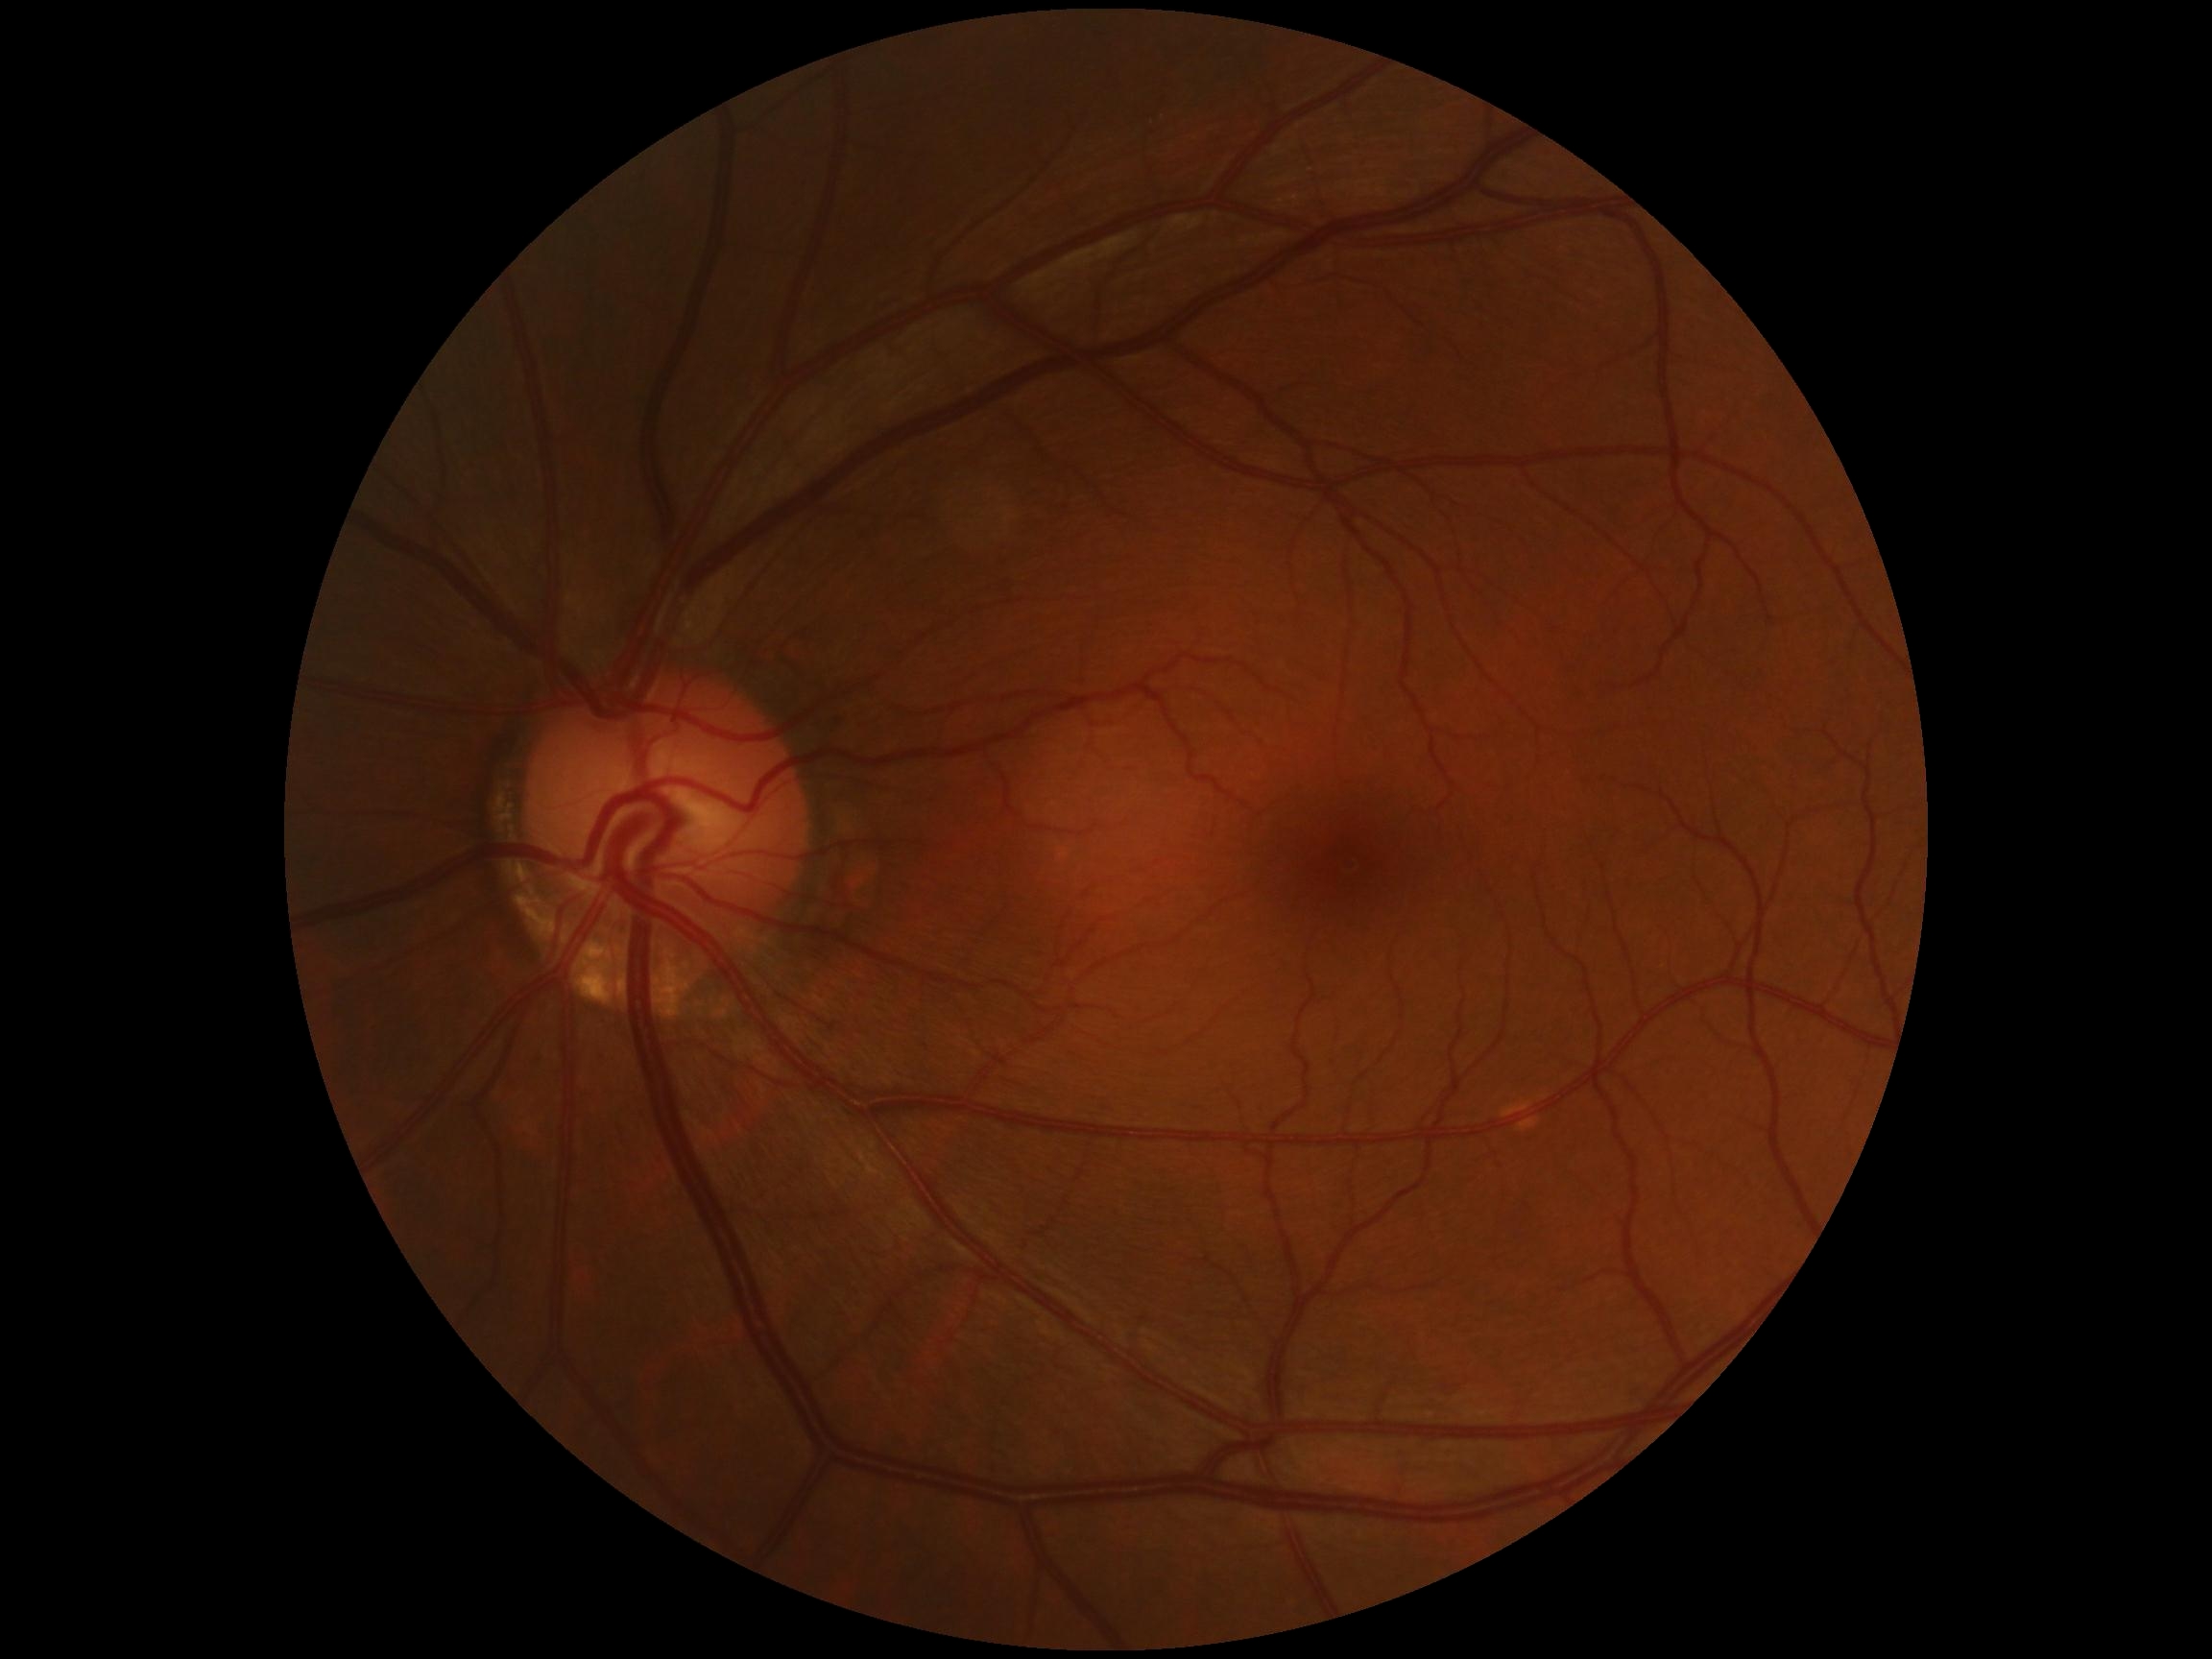 Diabetic retinopathy is no apparent diabetic retinopathy (grade 0) — no visible signs of diabetic retinopathy.